45° field of view.
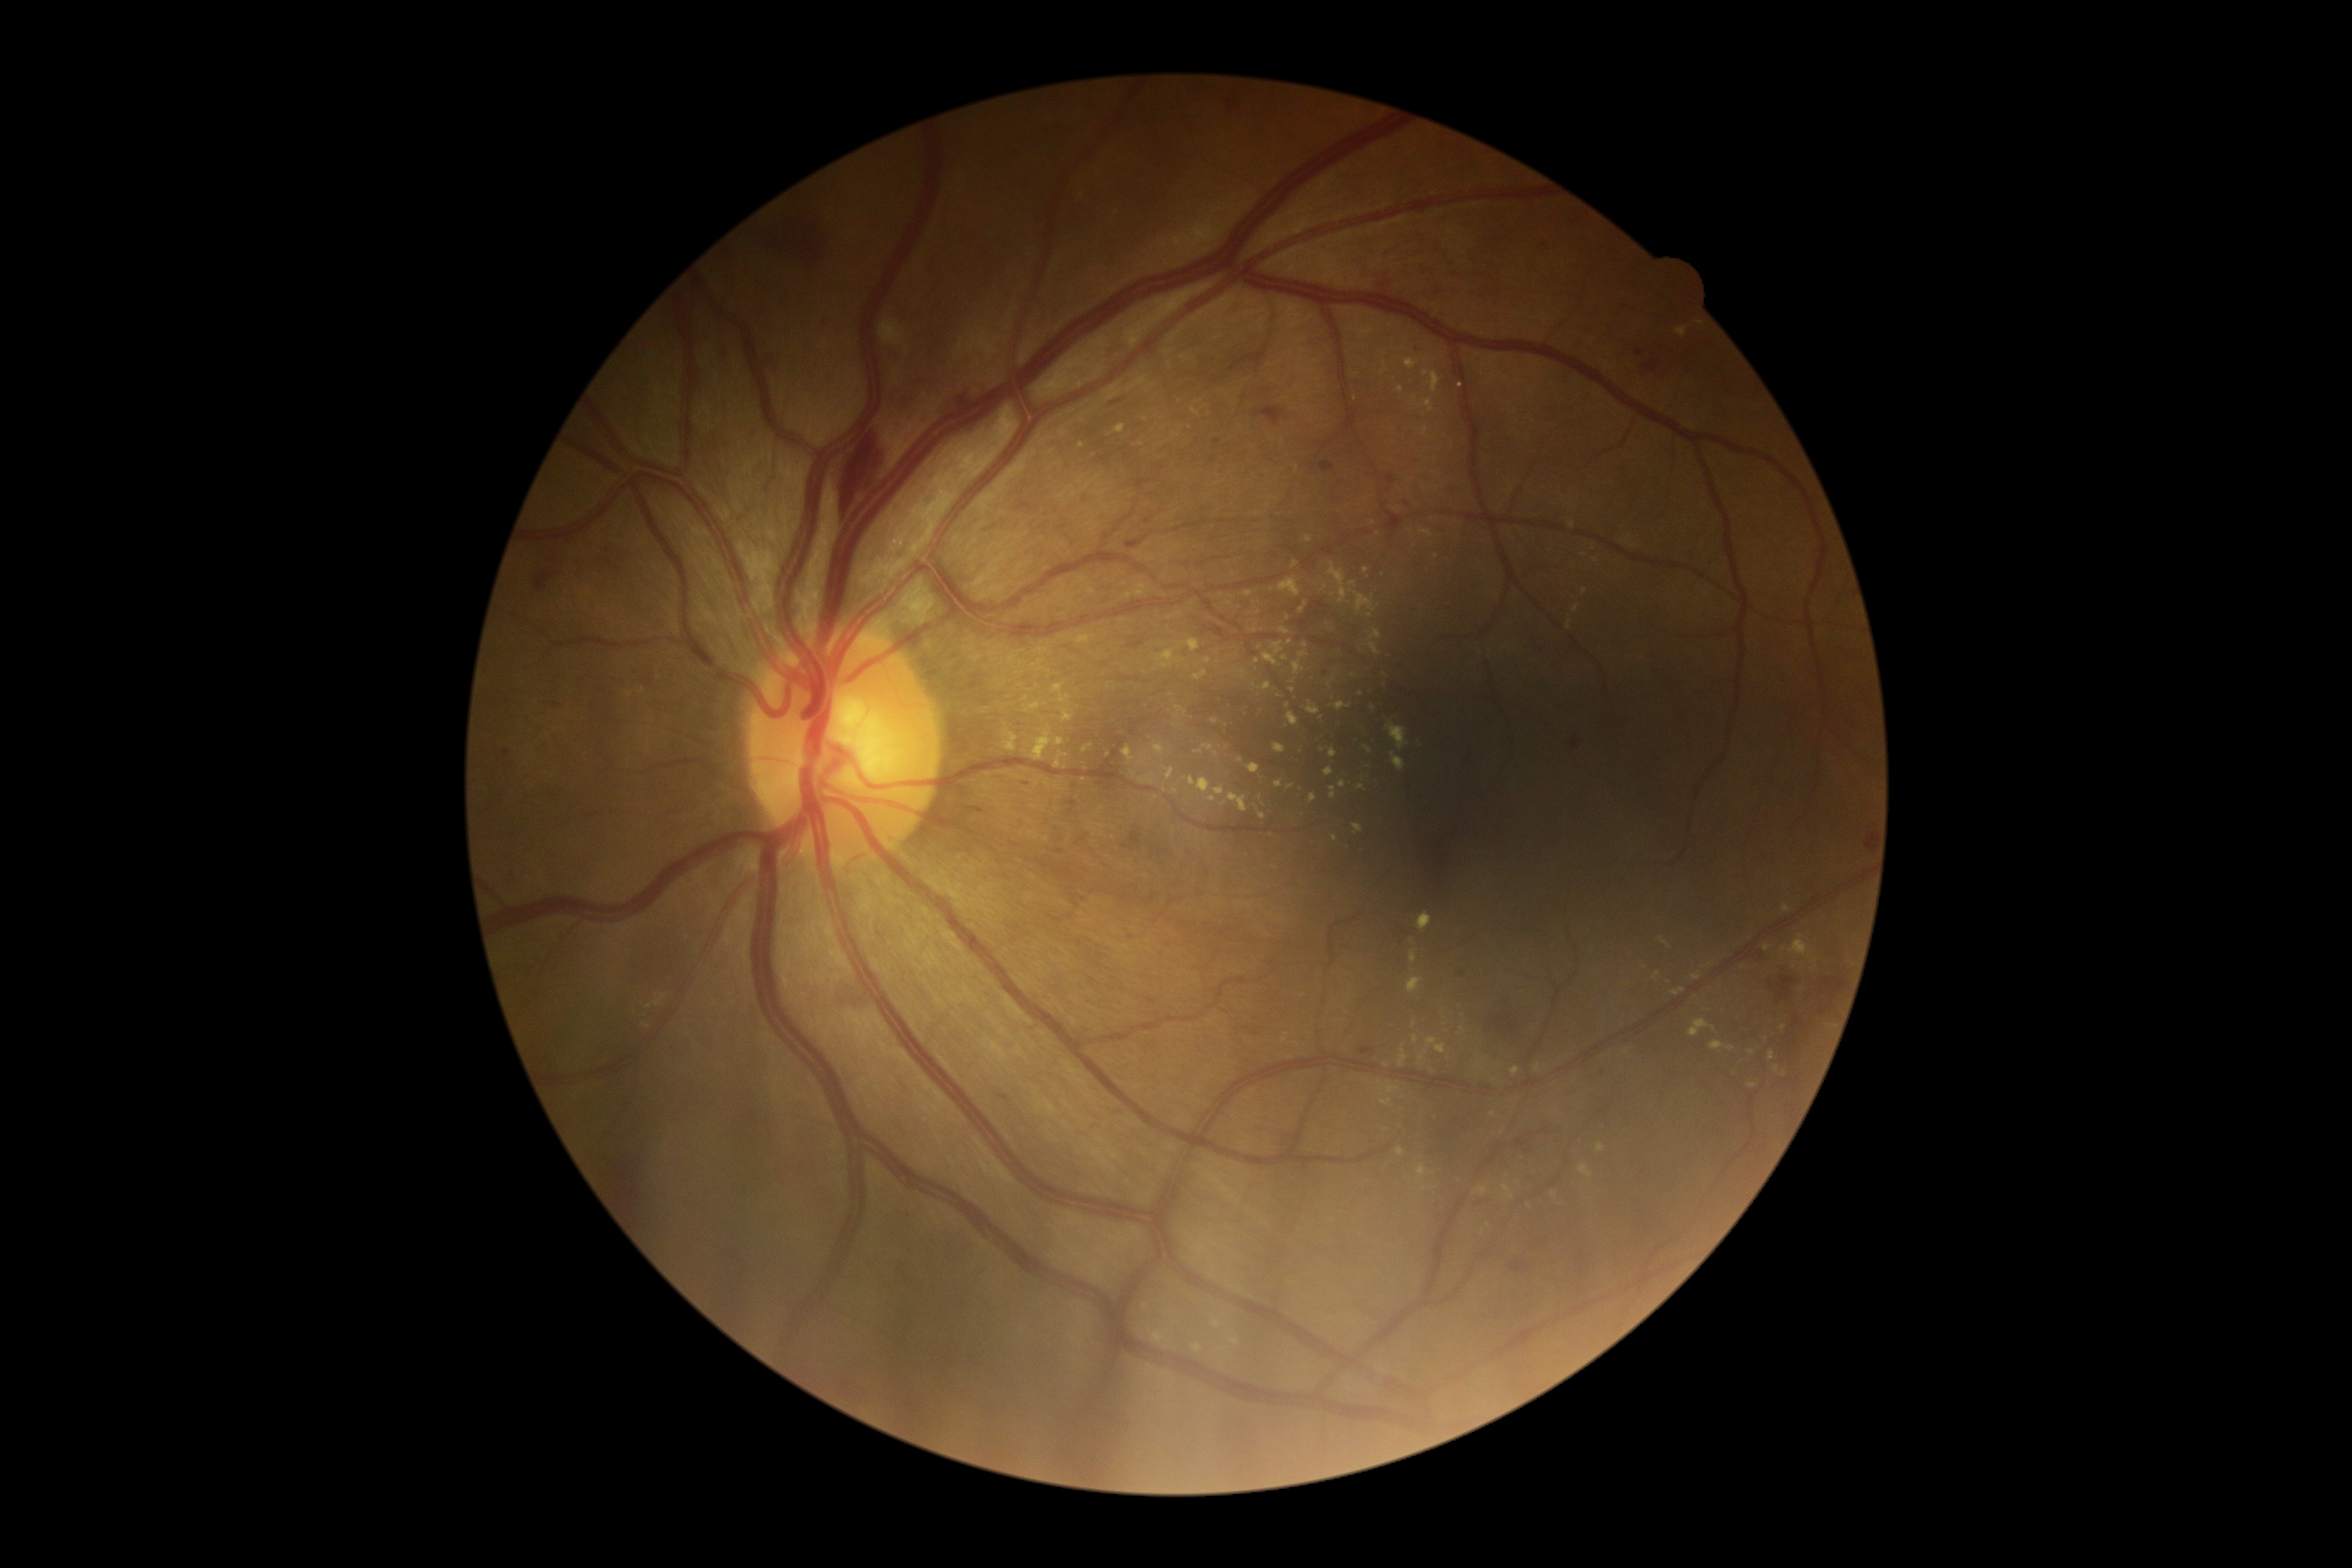

DR severity@2.